Ultra-widefield fundus photograph; FOV: 200 degrees; 1924x1556px.
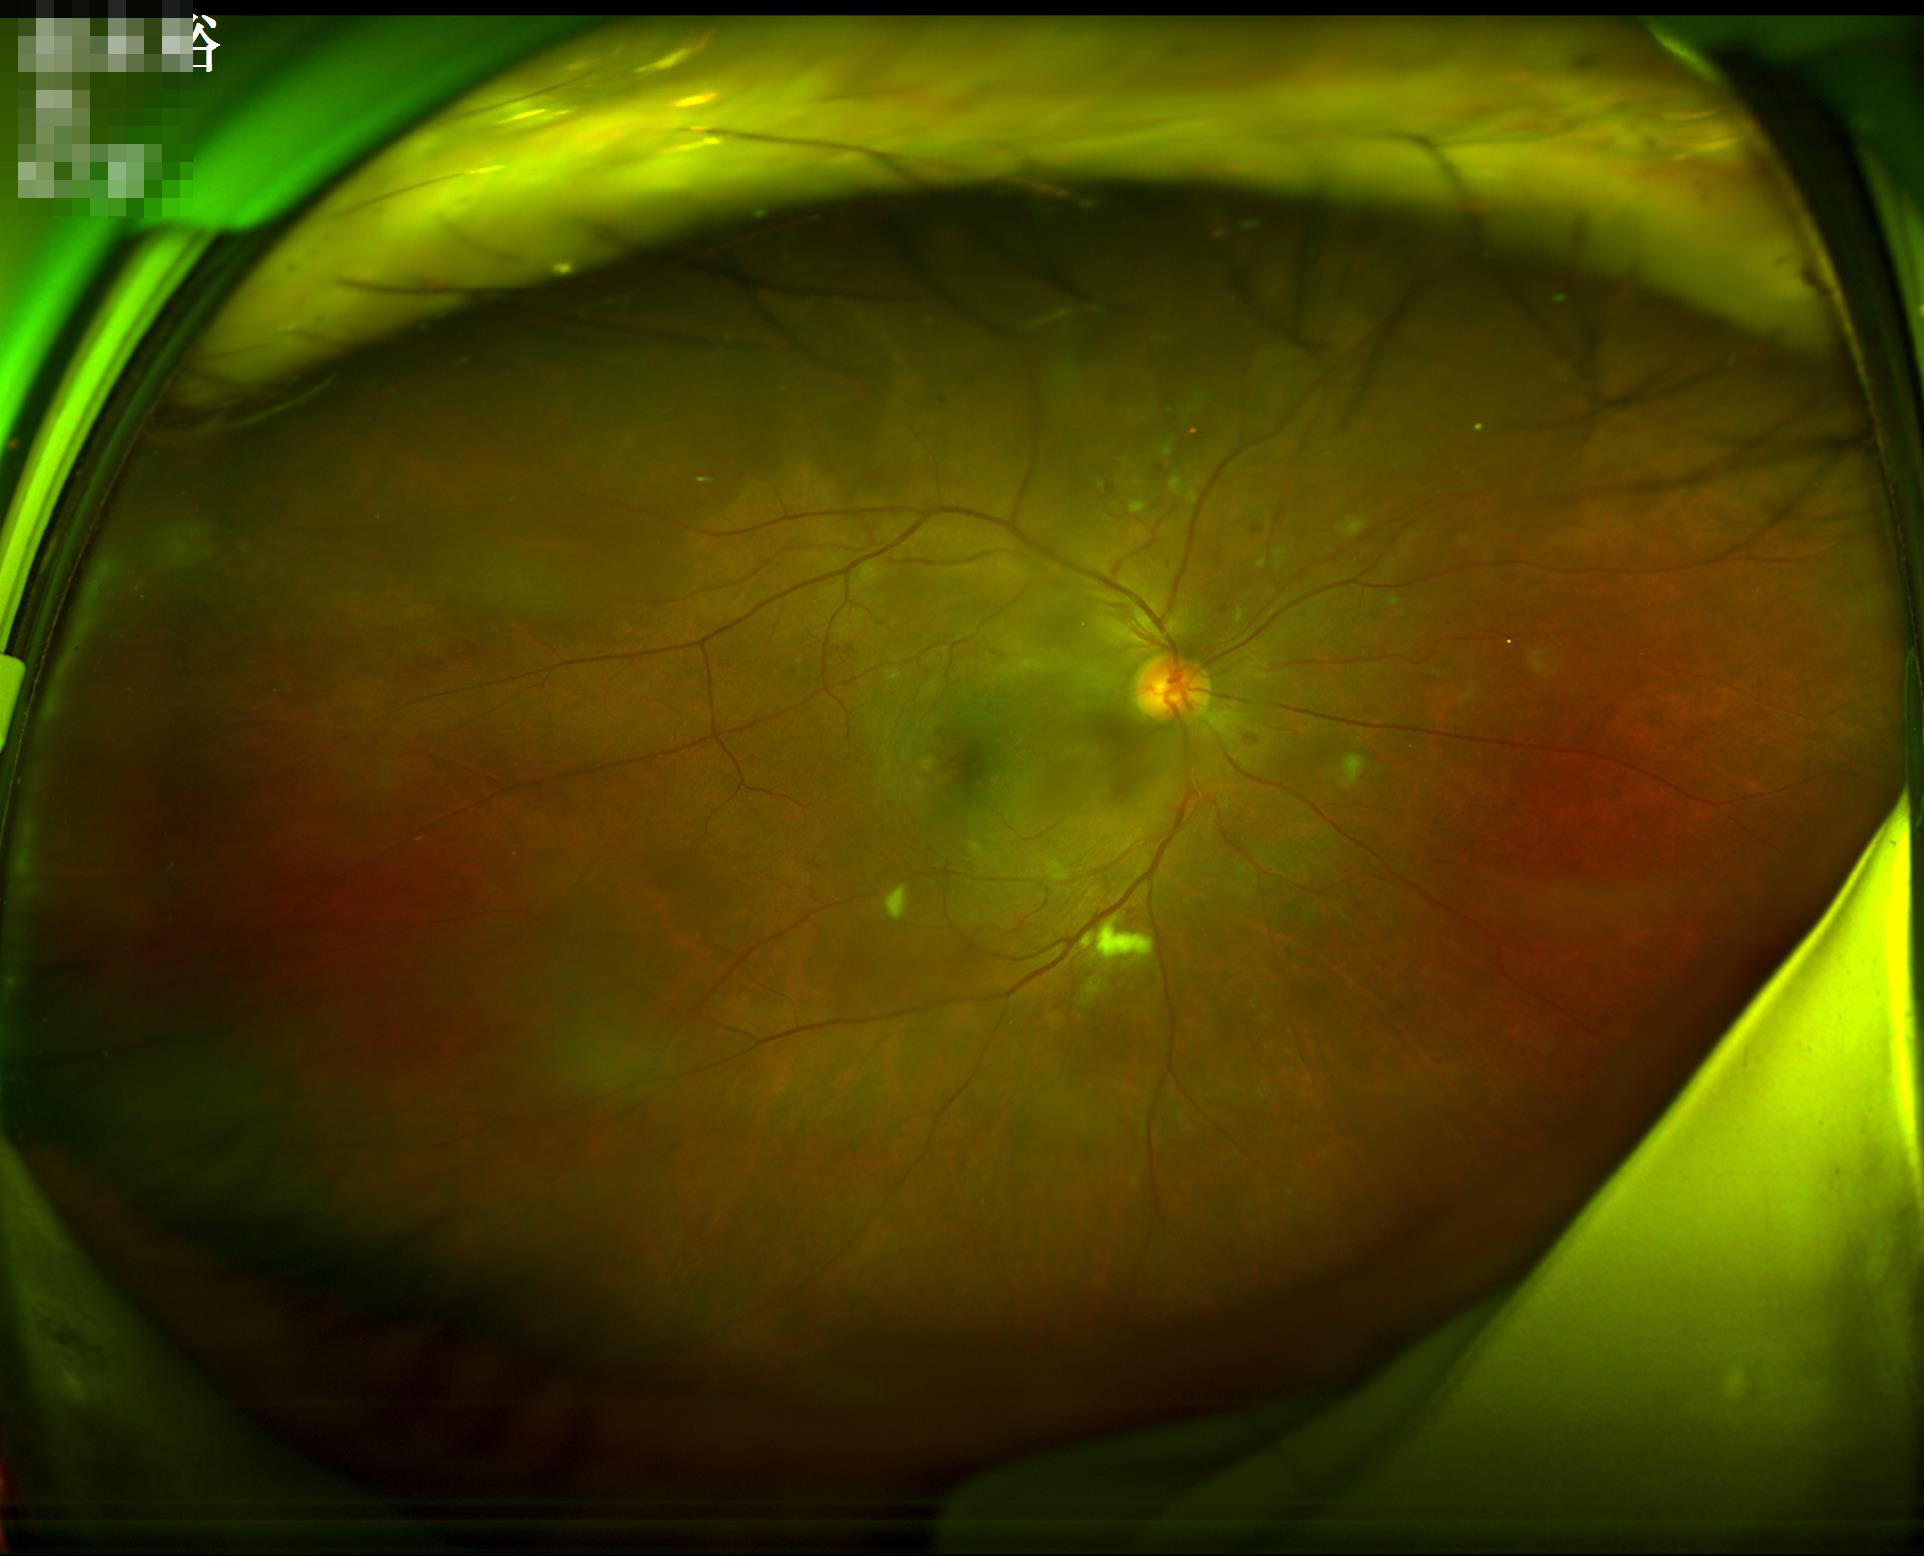
Noticeable blur in the optic disc, vessels, or background.
Illumination is even.
Good dynamic range.
Overall image quality is good.